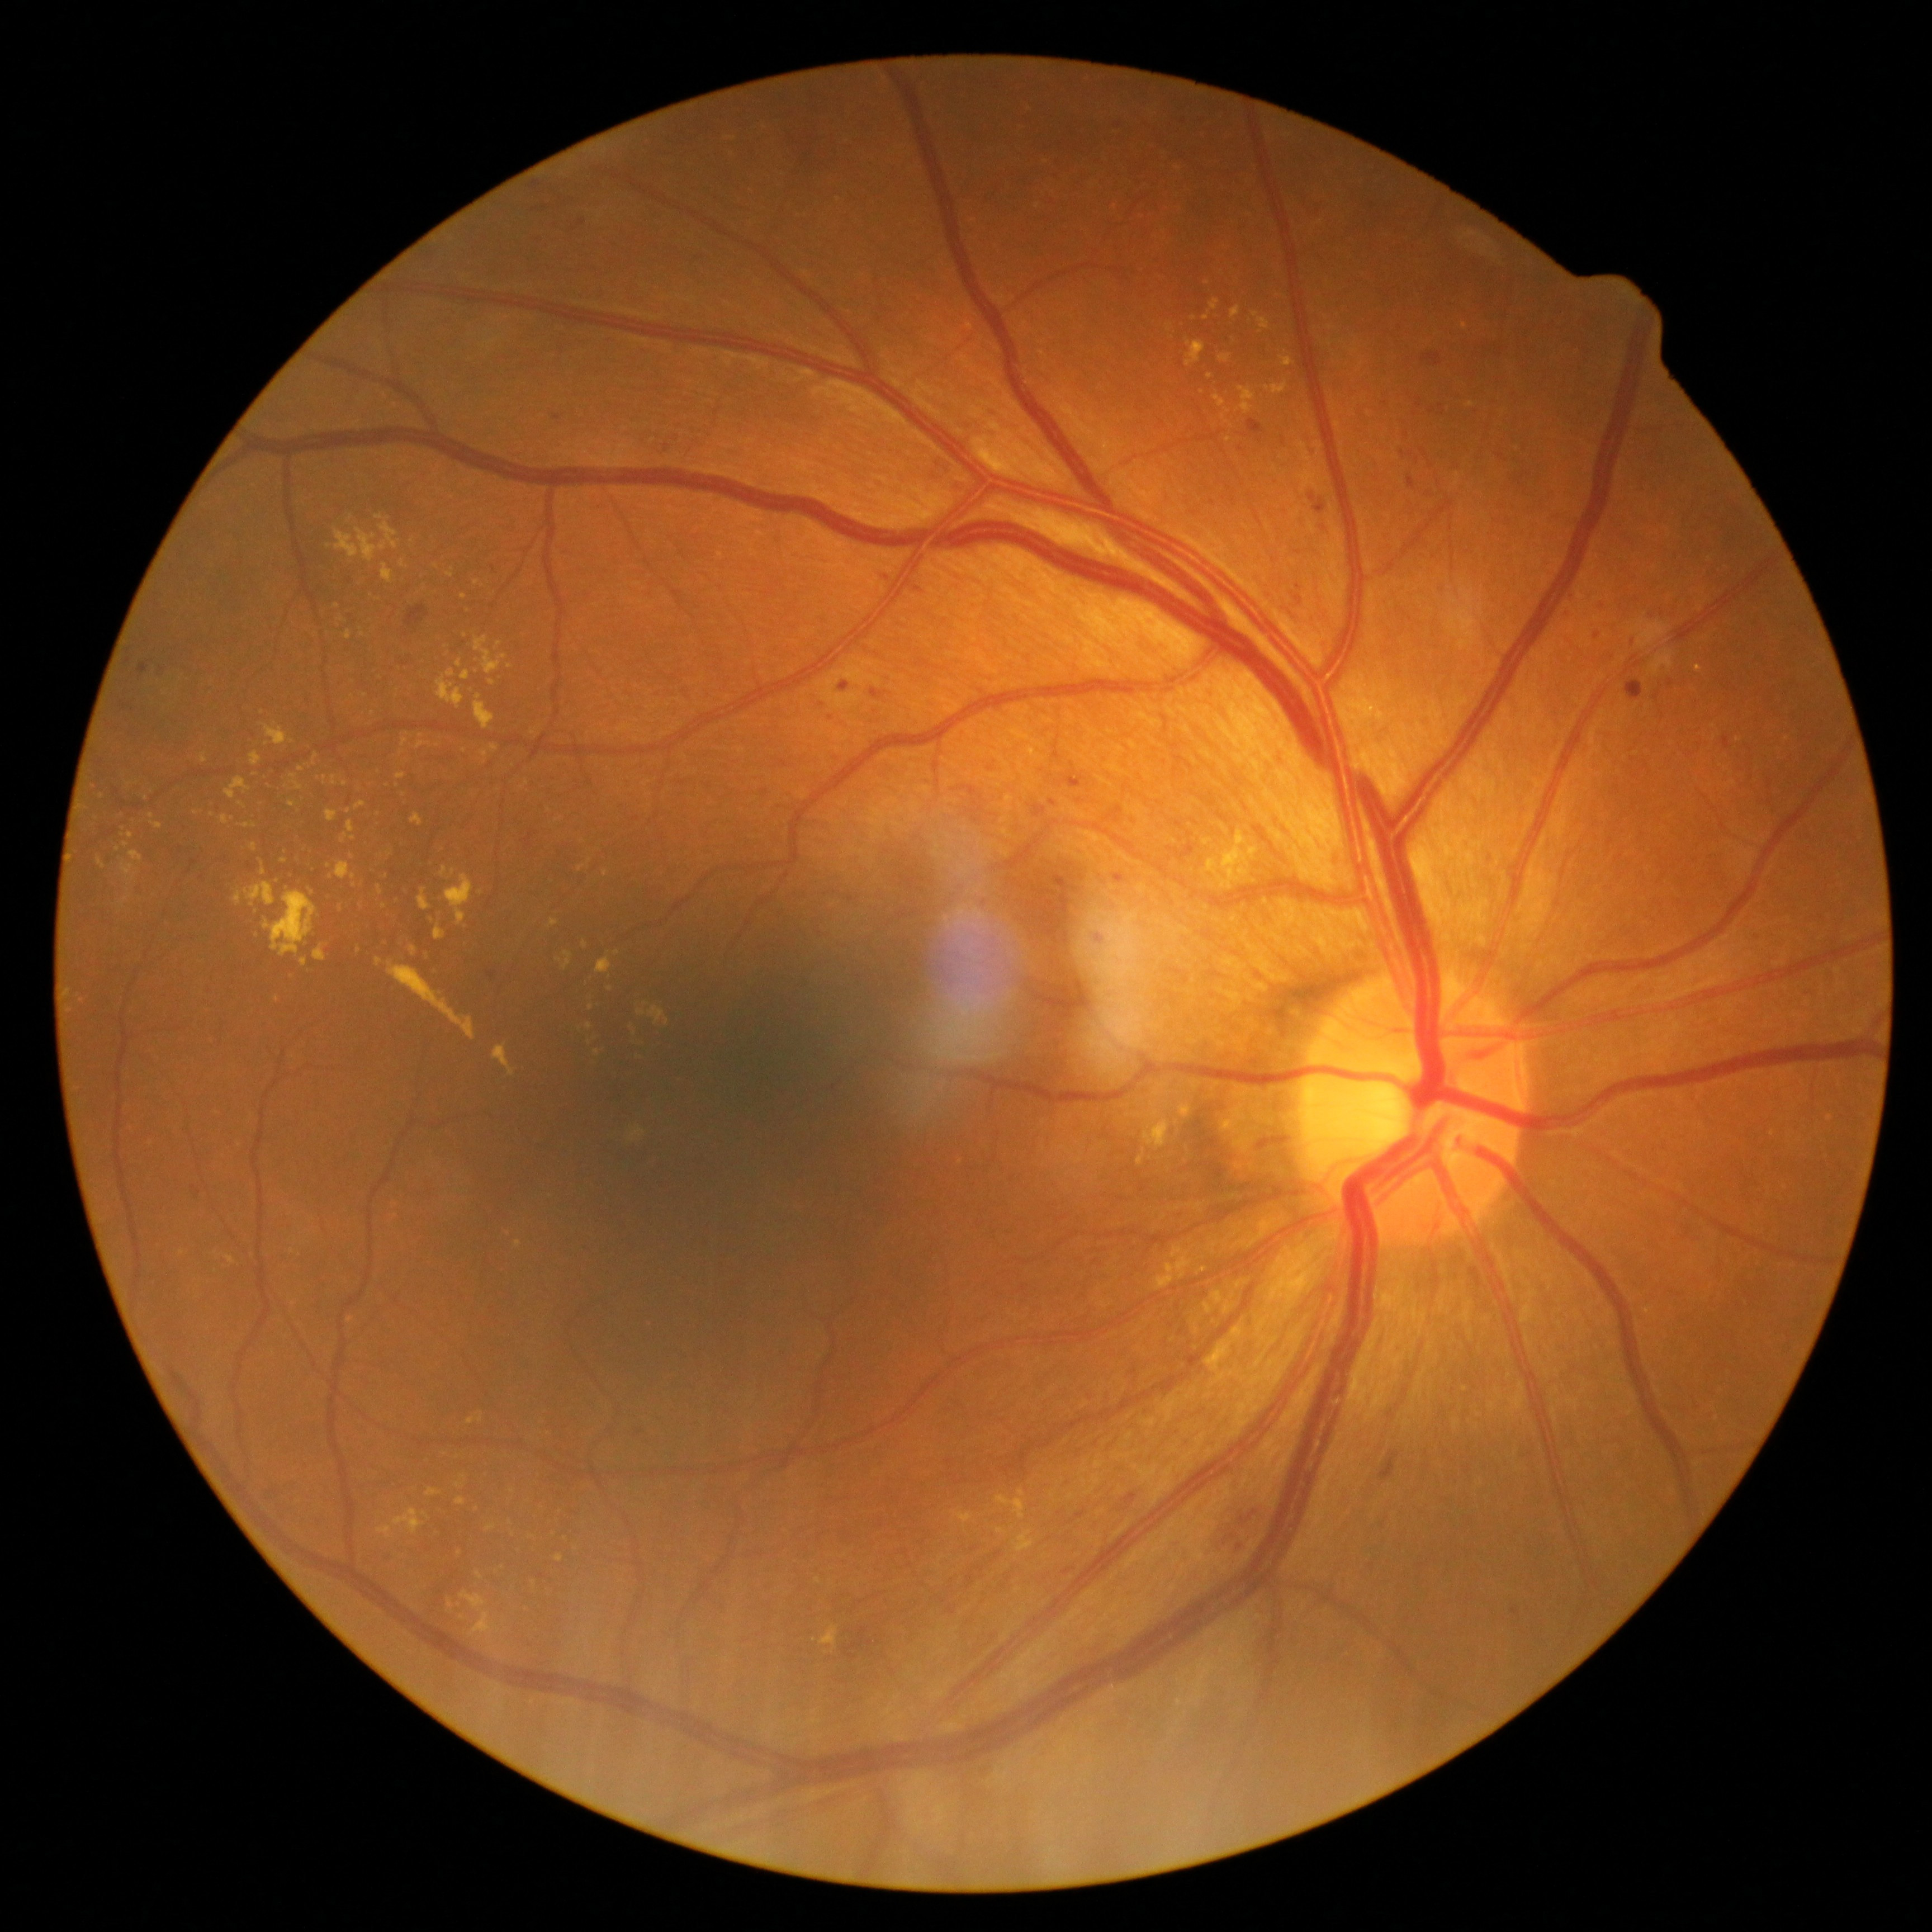

{"partial":true,"dr_grade":2,"dr_grade_name":"moderate NPDR","lesions":{"ex":[[332,776,337,785],[997,1527,1007,1535],[121,895,131,907],[410,813,423,827],[583,941,589,949],[562,952,574,970],[378,1508,424,1538],[820,1626,838,1647],[456,1497,466,1505],[480,751,488,759],[396,774,406,780],[493,1044,515,1076]],"ex_small_centers":[[598,1053],[398,785],[262,863],[559,960],[118,849],[125,845],[431,920]]}}